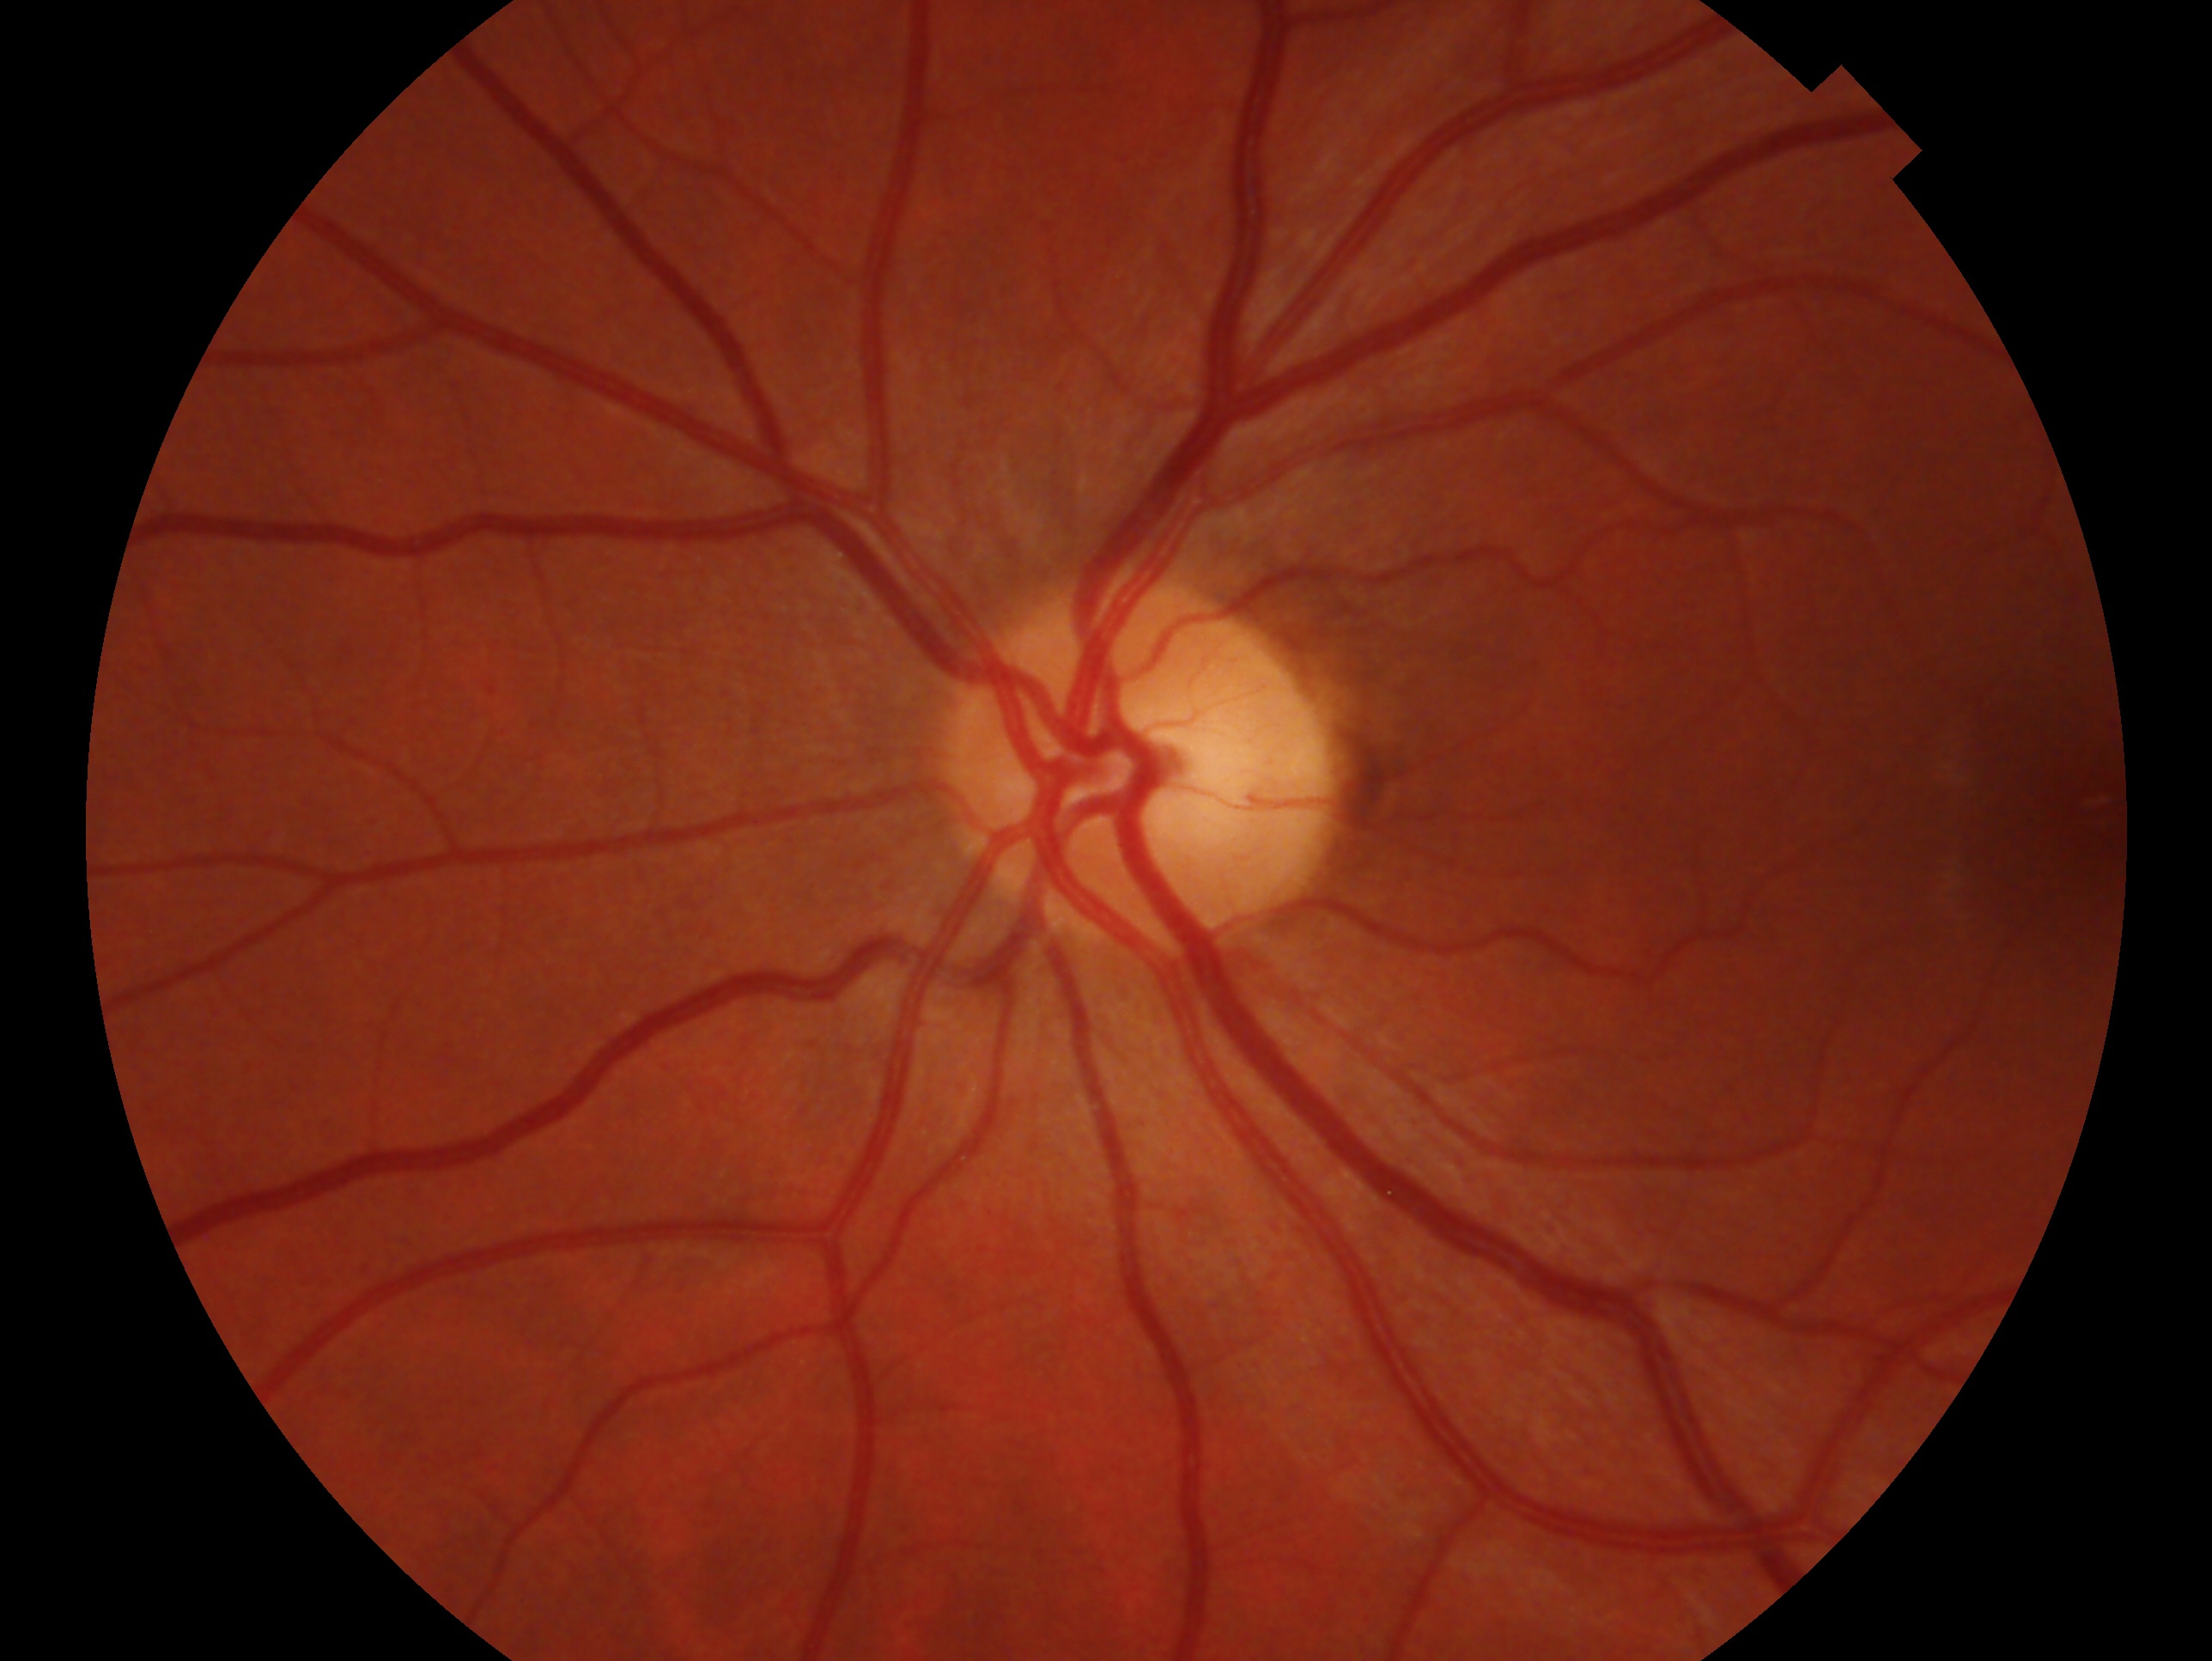

- diagnosis: no signs of glaucoma
- eye: OS